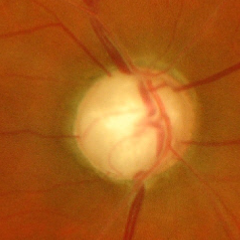
Glaucomatous changes are present. Assessment = severe glaucomatous damage.